Wide-field contact fundus photograph of an infant · 640 x 480 pixels · 130° field of view (Clarity RetCam 3)
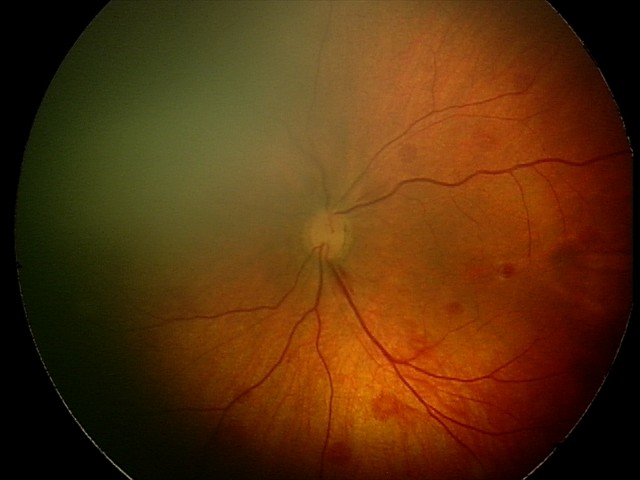
Screening diagnosis: retinal hemorrhages.